Pediatric wide-field fundus photograph. Camera: Phoenix ICON (100° FOV). 1240x1240px
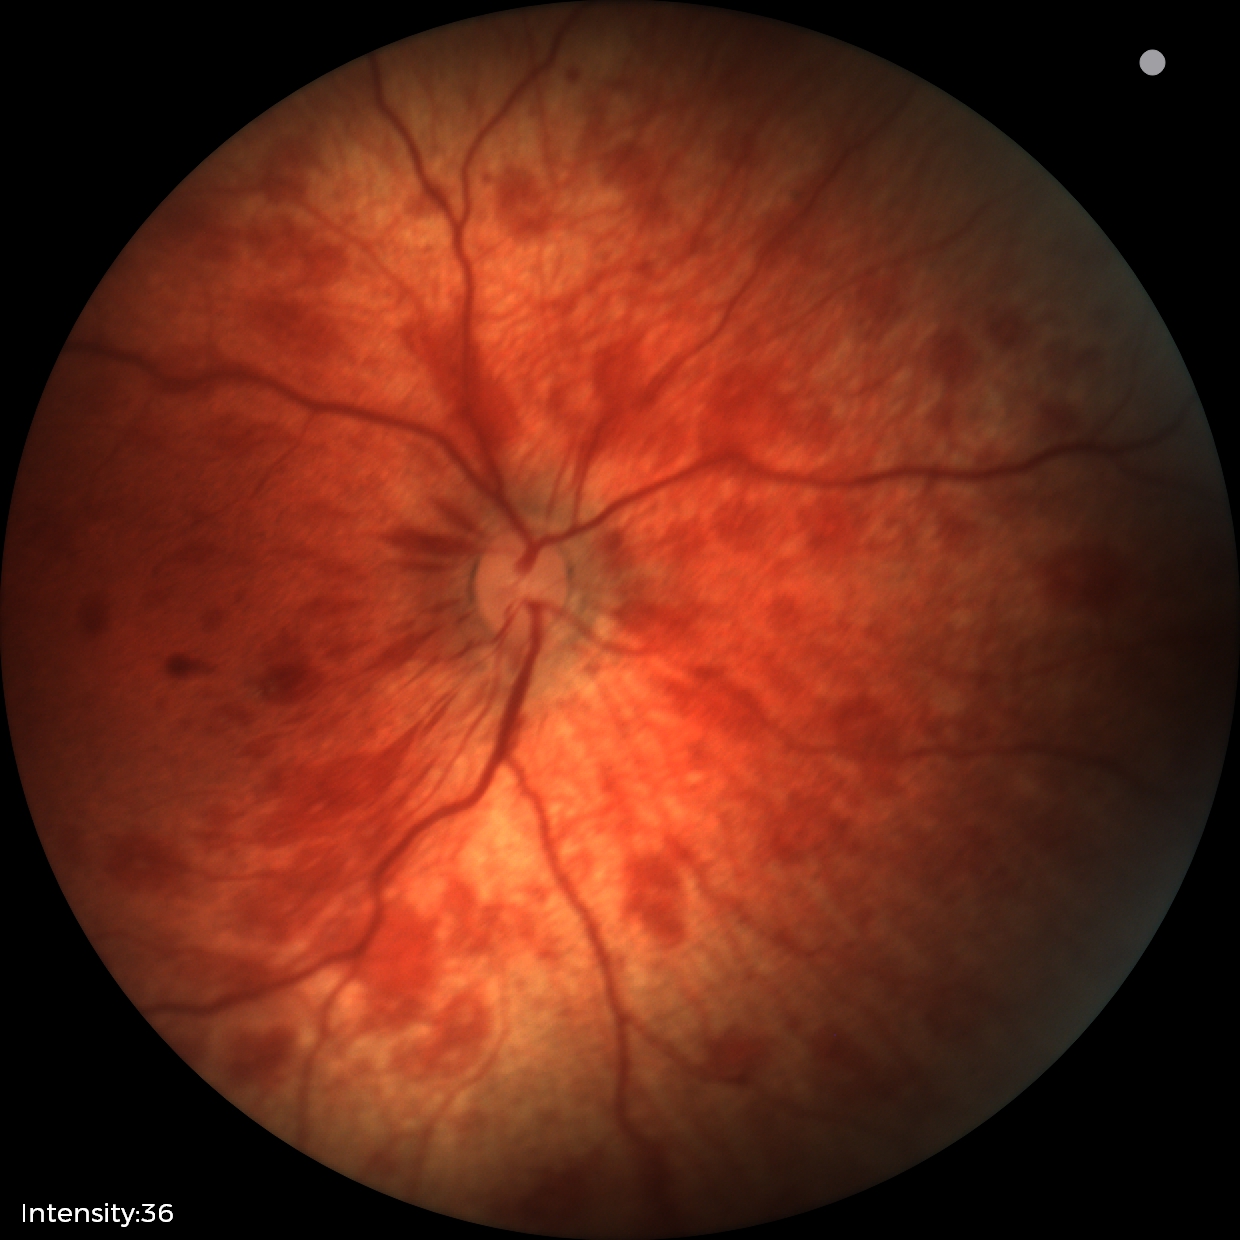

Screening examination consistent with retinal hemorrhages.